FOV: 45 degrees — 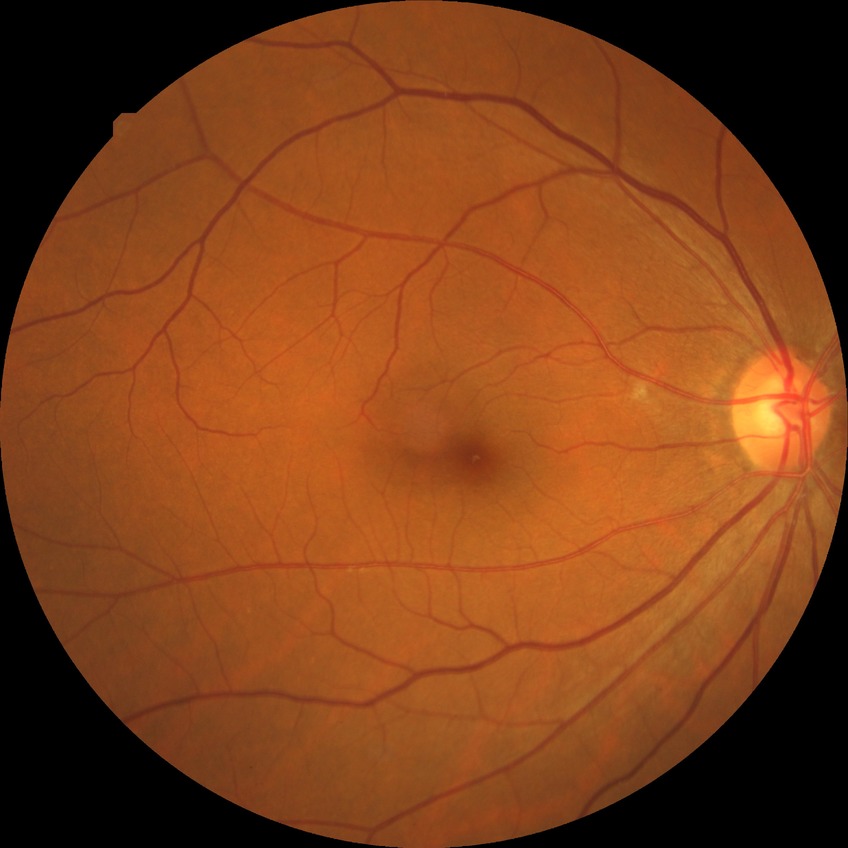 Retinopathy stage is no diabetic retinopathy.